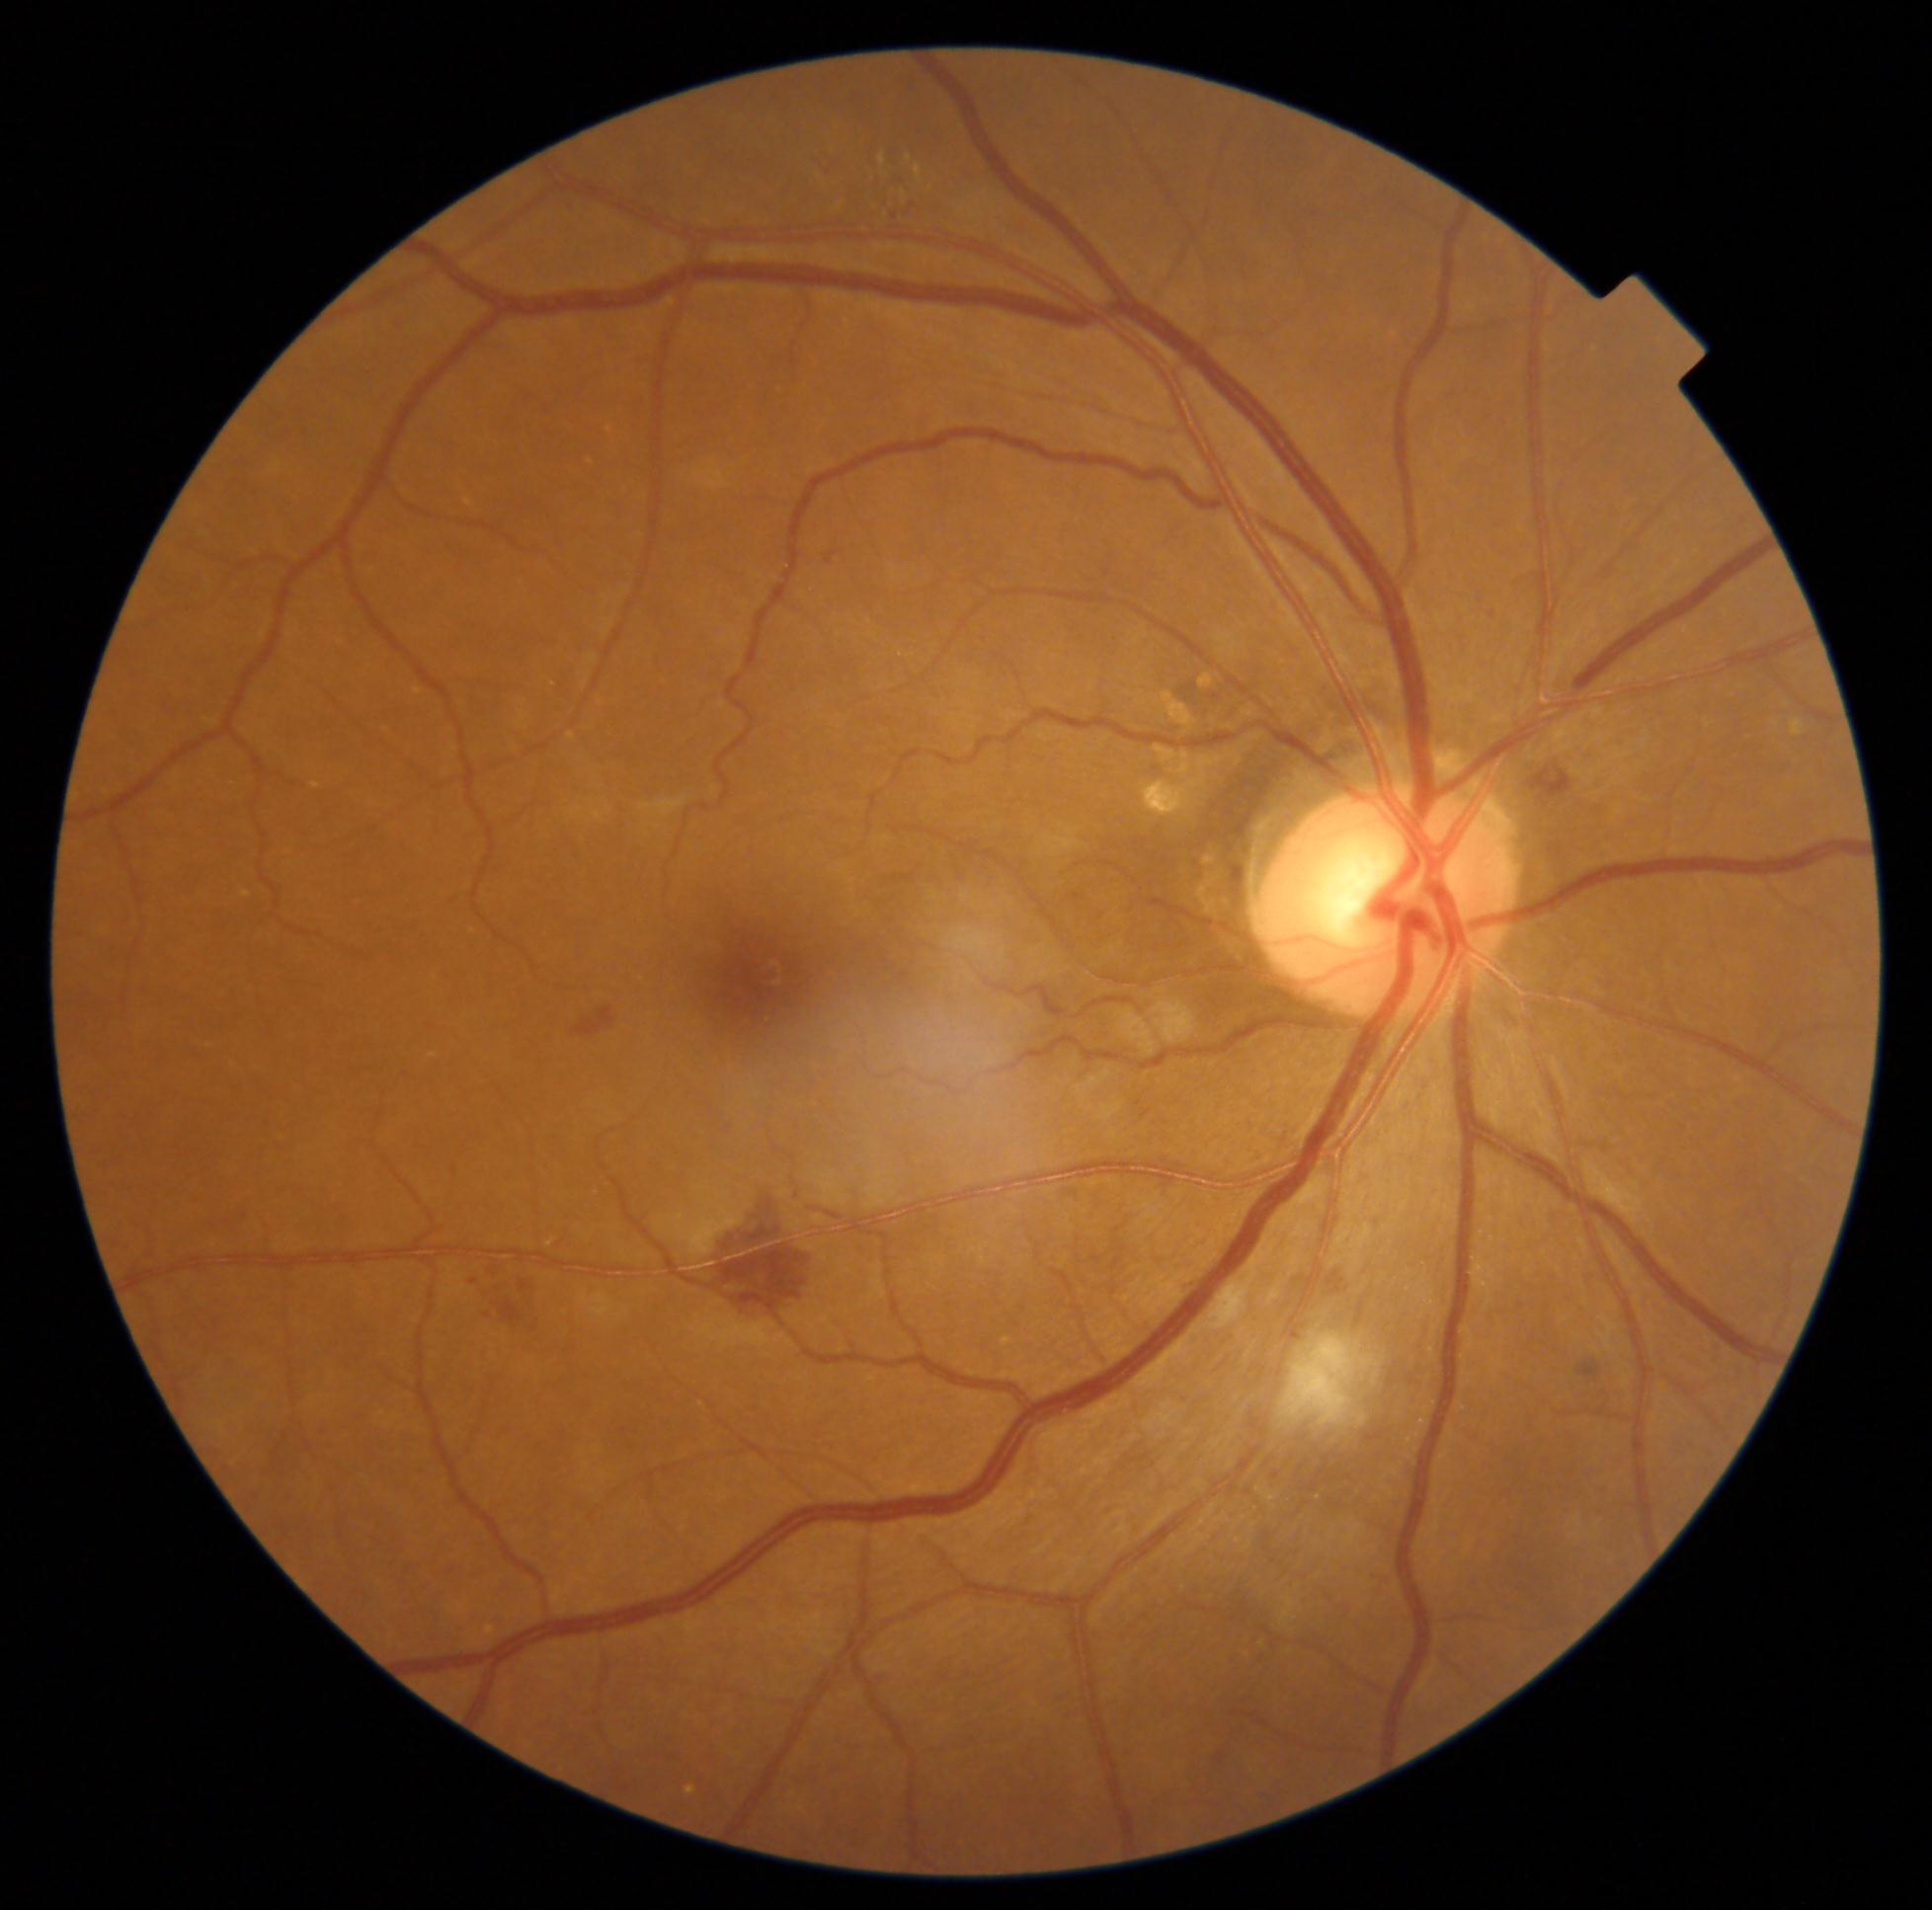 Retinopathy is moderate non-proliferative diabetic retinopathy (grade 2).